Modified Davis classification; FOV: 45 degrees.
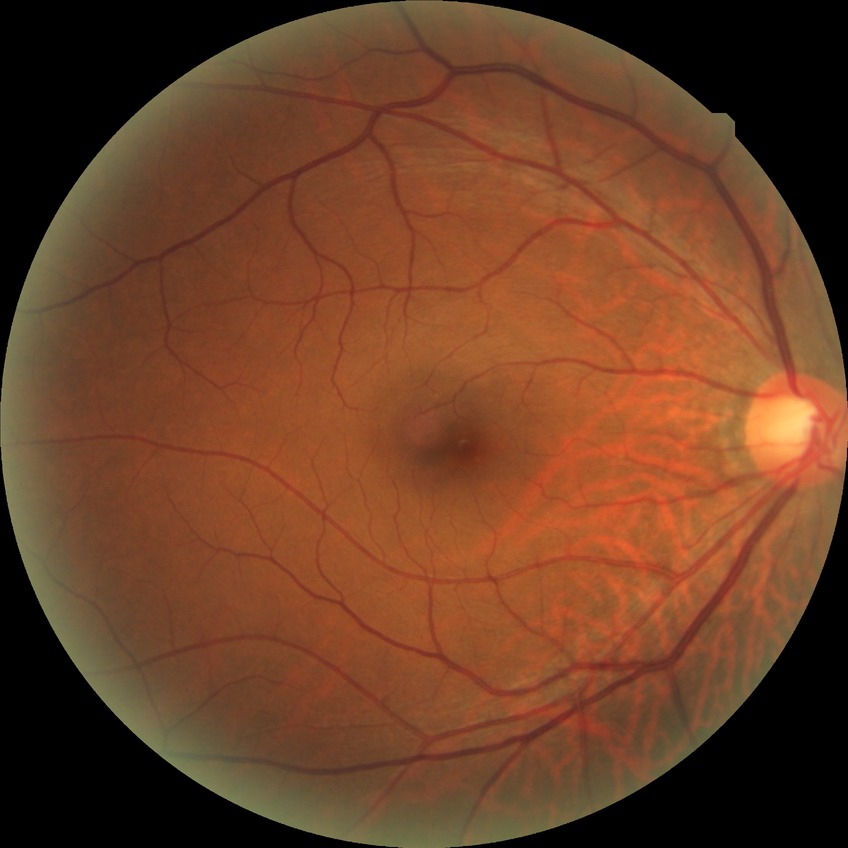

Assessment:
- diabetic retinopathy (DR): no diabetic retinopathy (NDR)